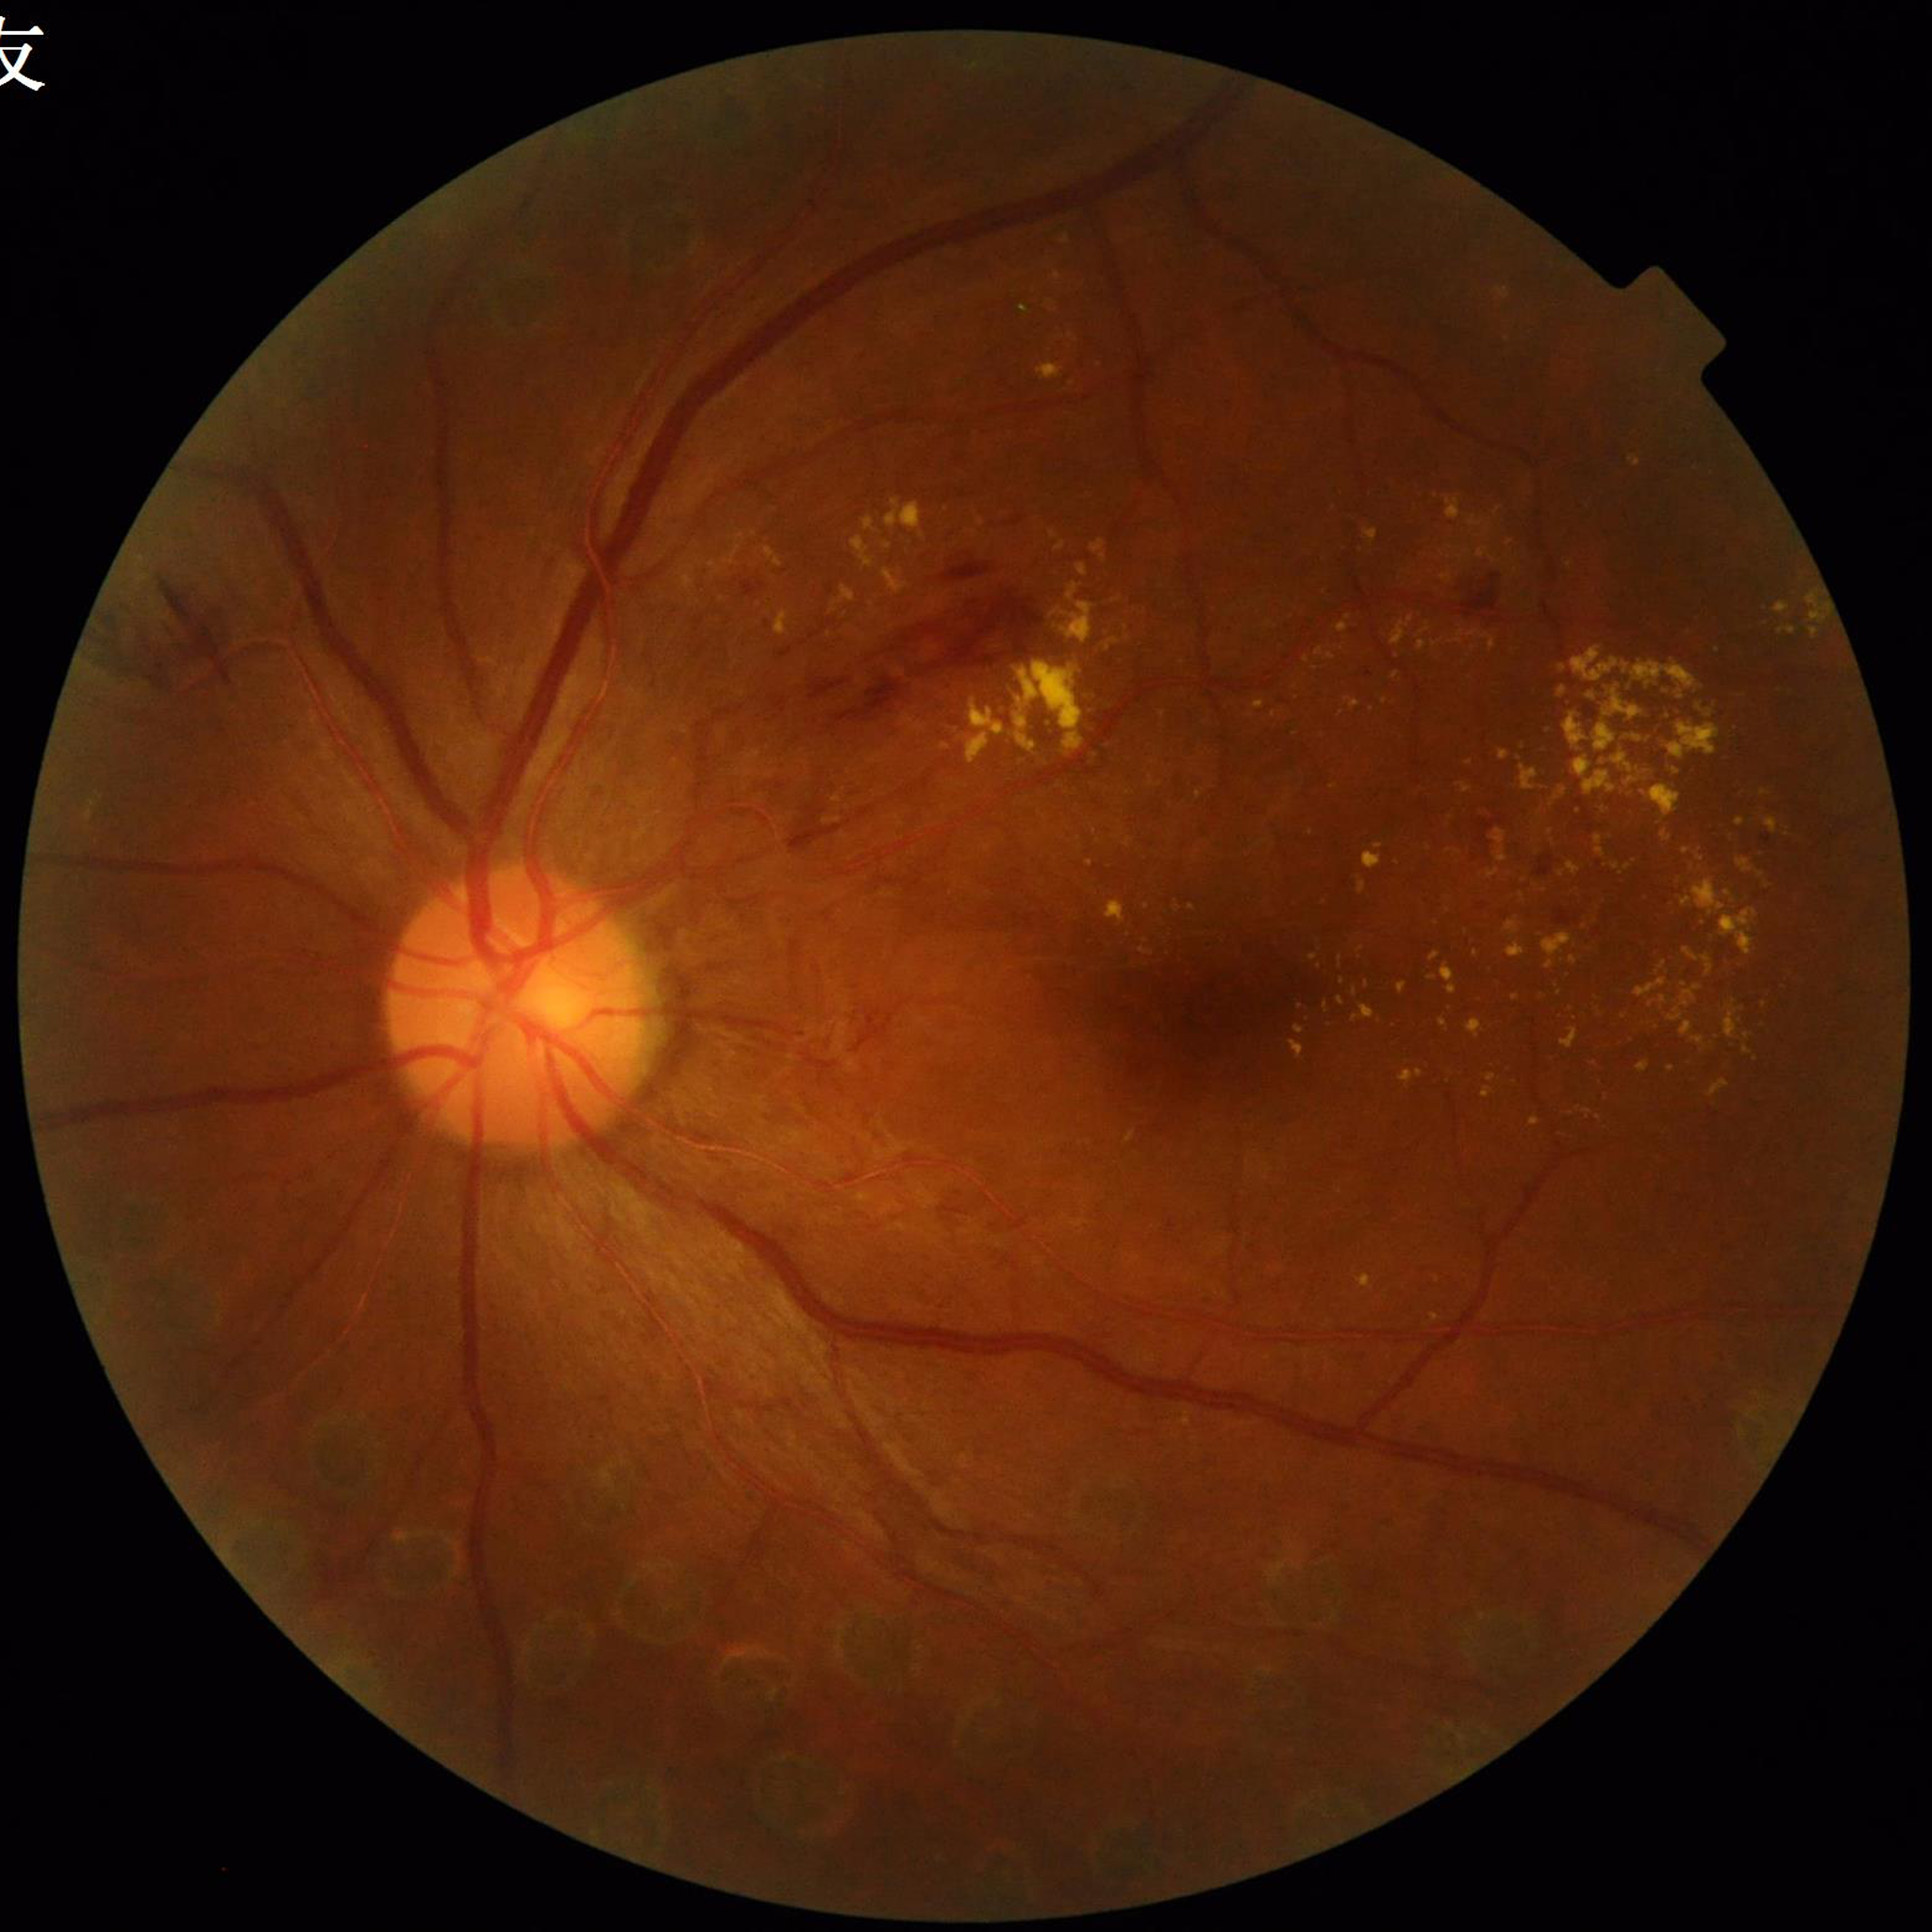 Retinal fundus photograph from a patient with DR. Quality assessment: no quality issues identified.